2048 x 1536 pixels · color fundus photograph · 45-degree field of view
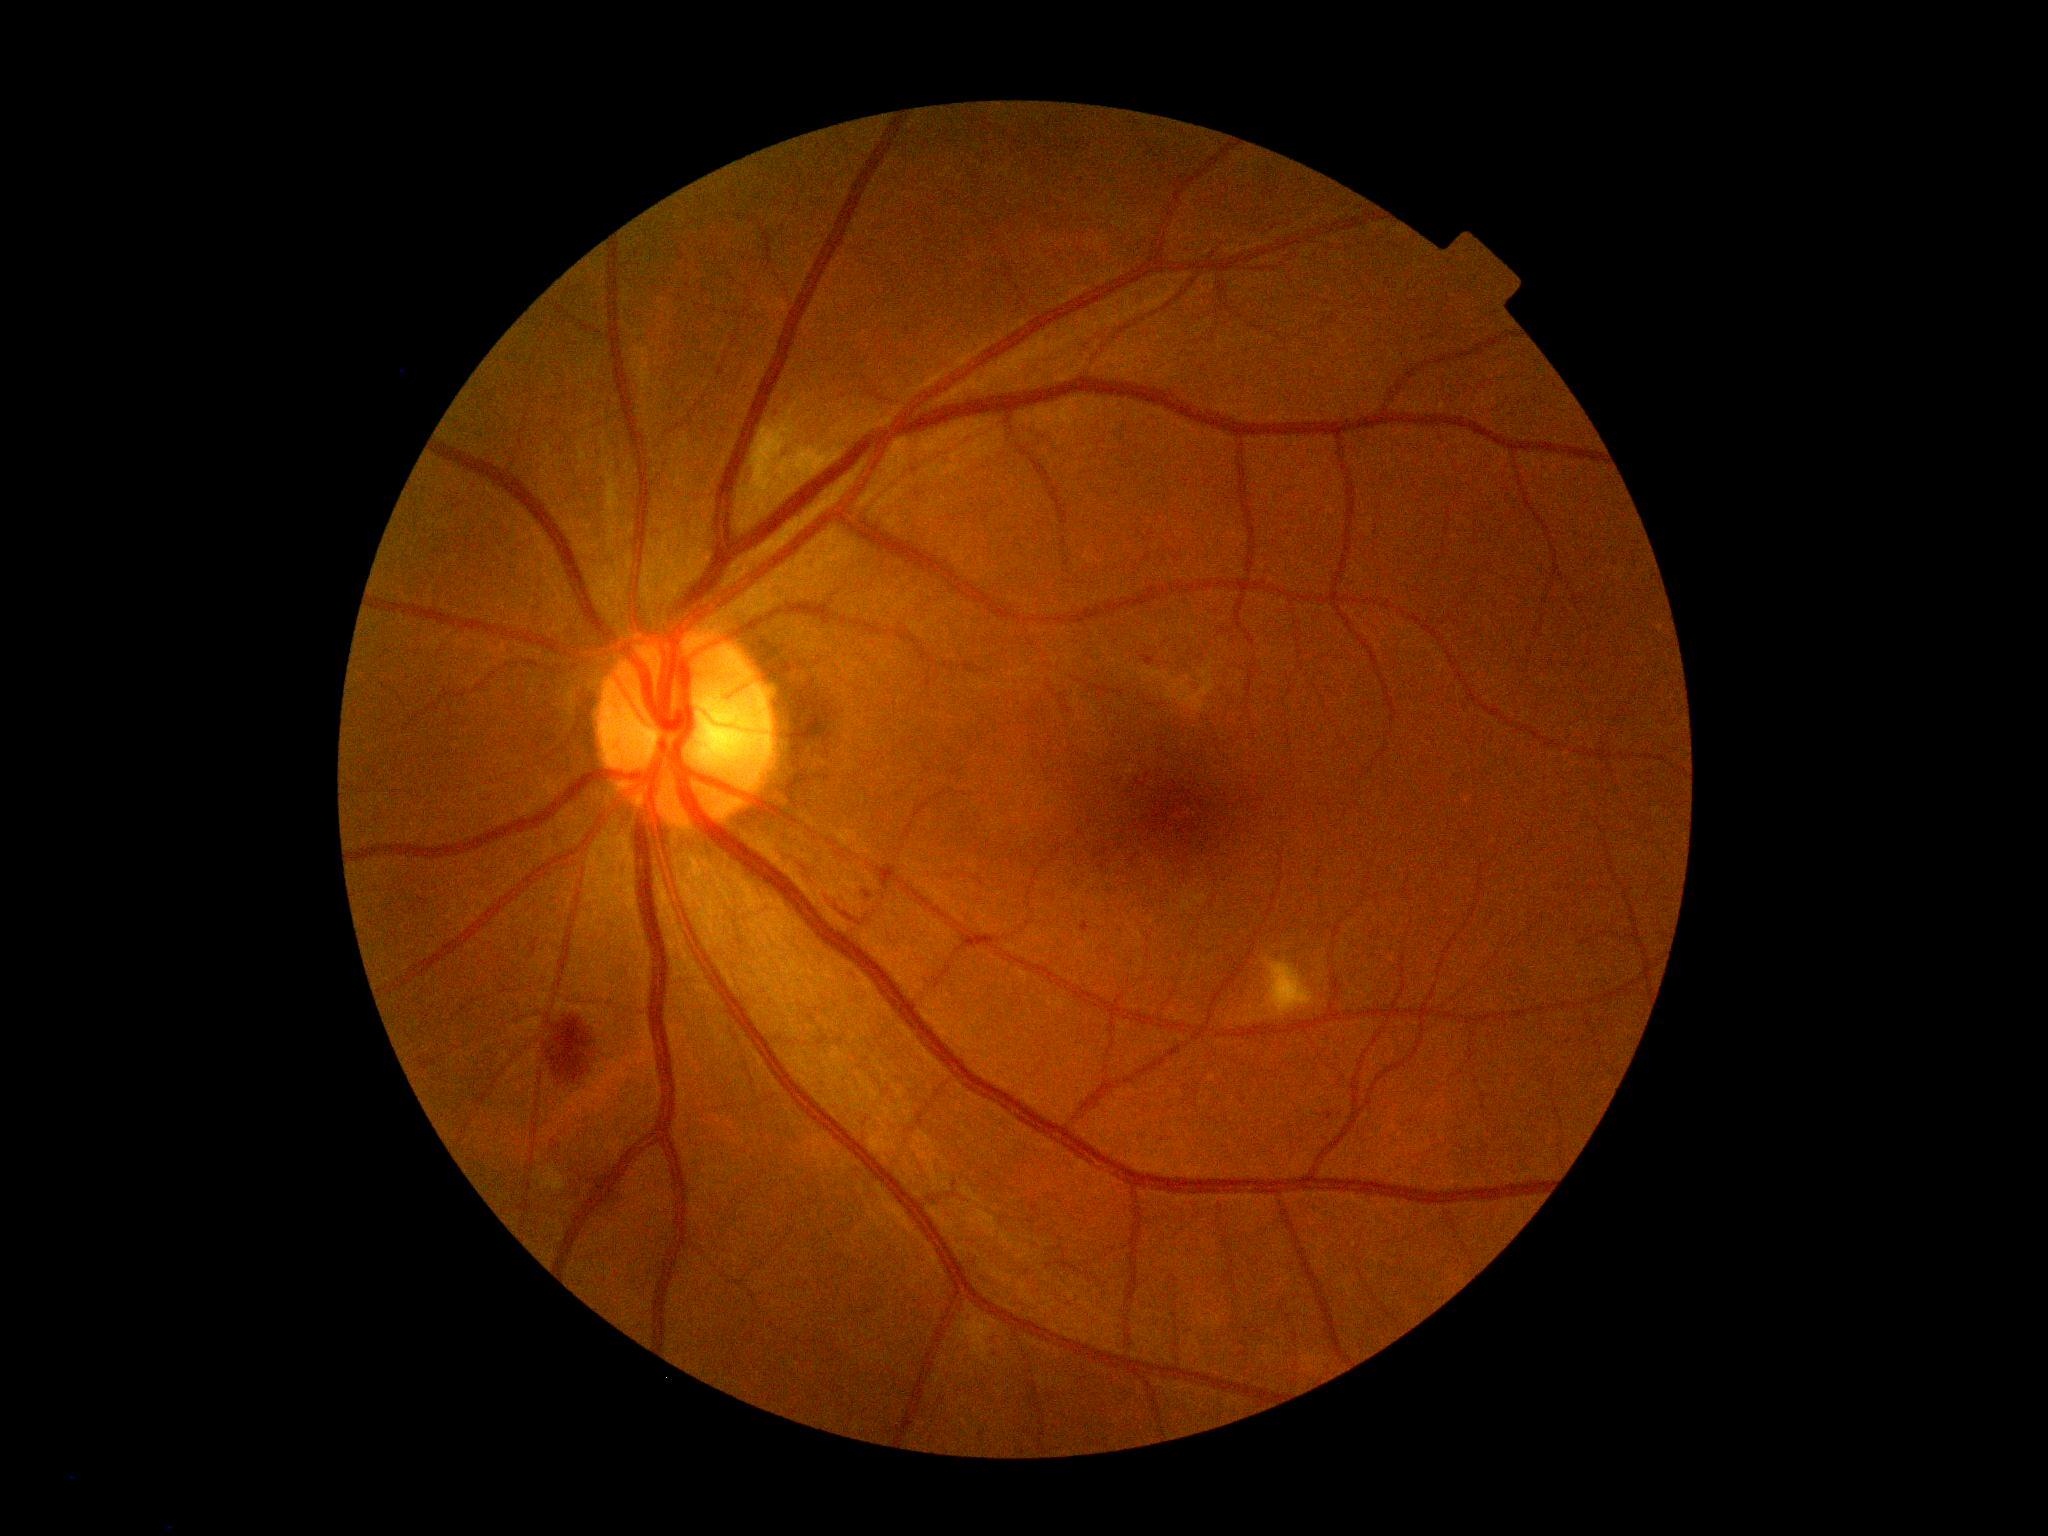 {"dr_grade": "2 (moderate NPDR)"}